Image size 2048x1536; fundus photo; FOV: 45 degrees — 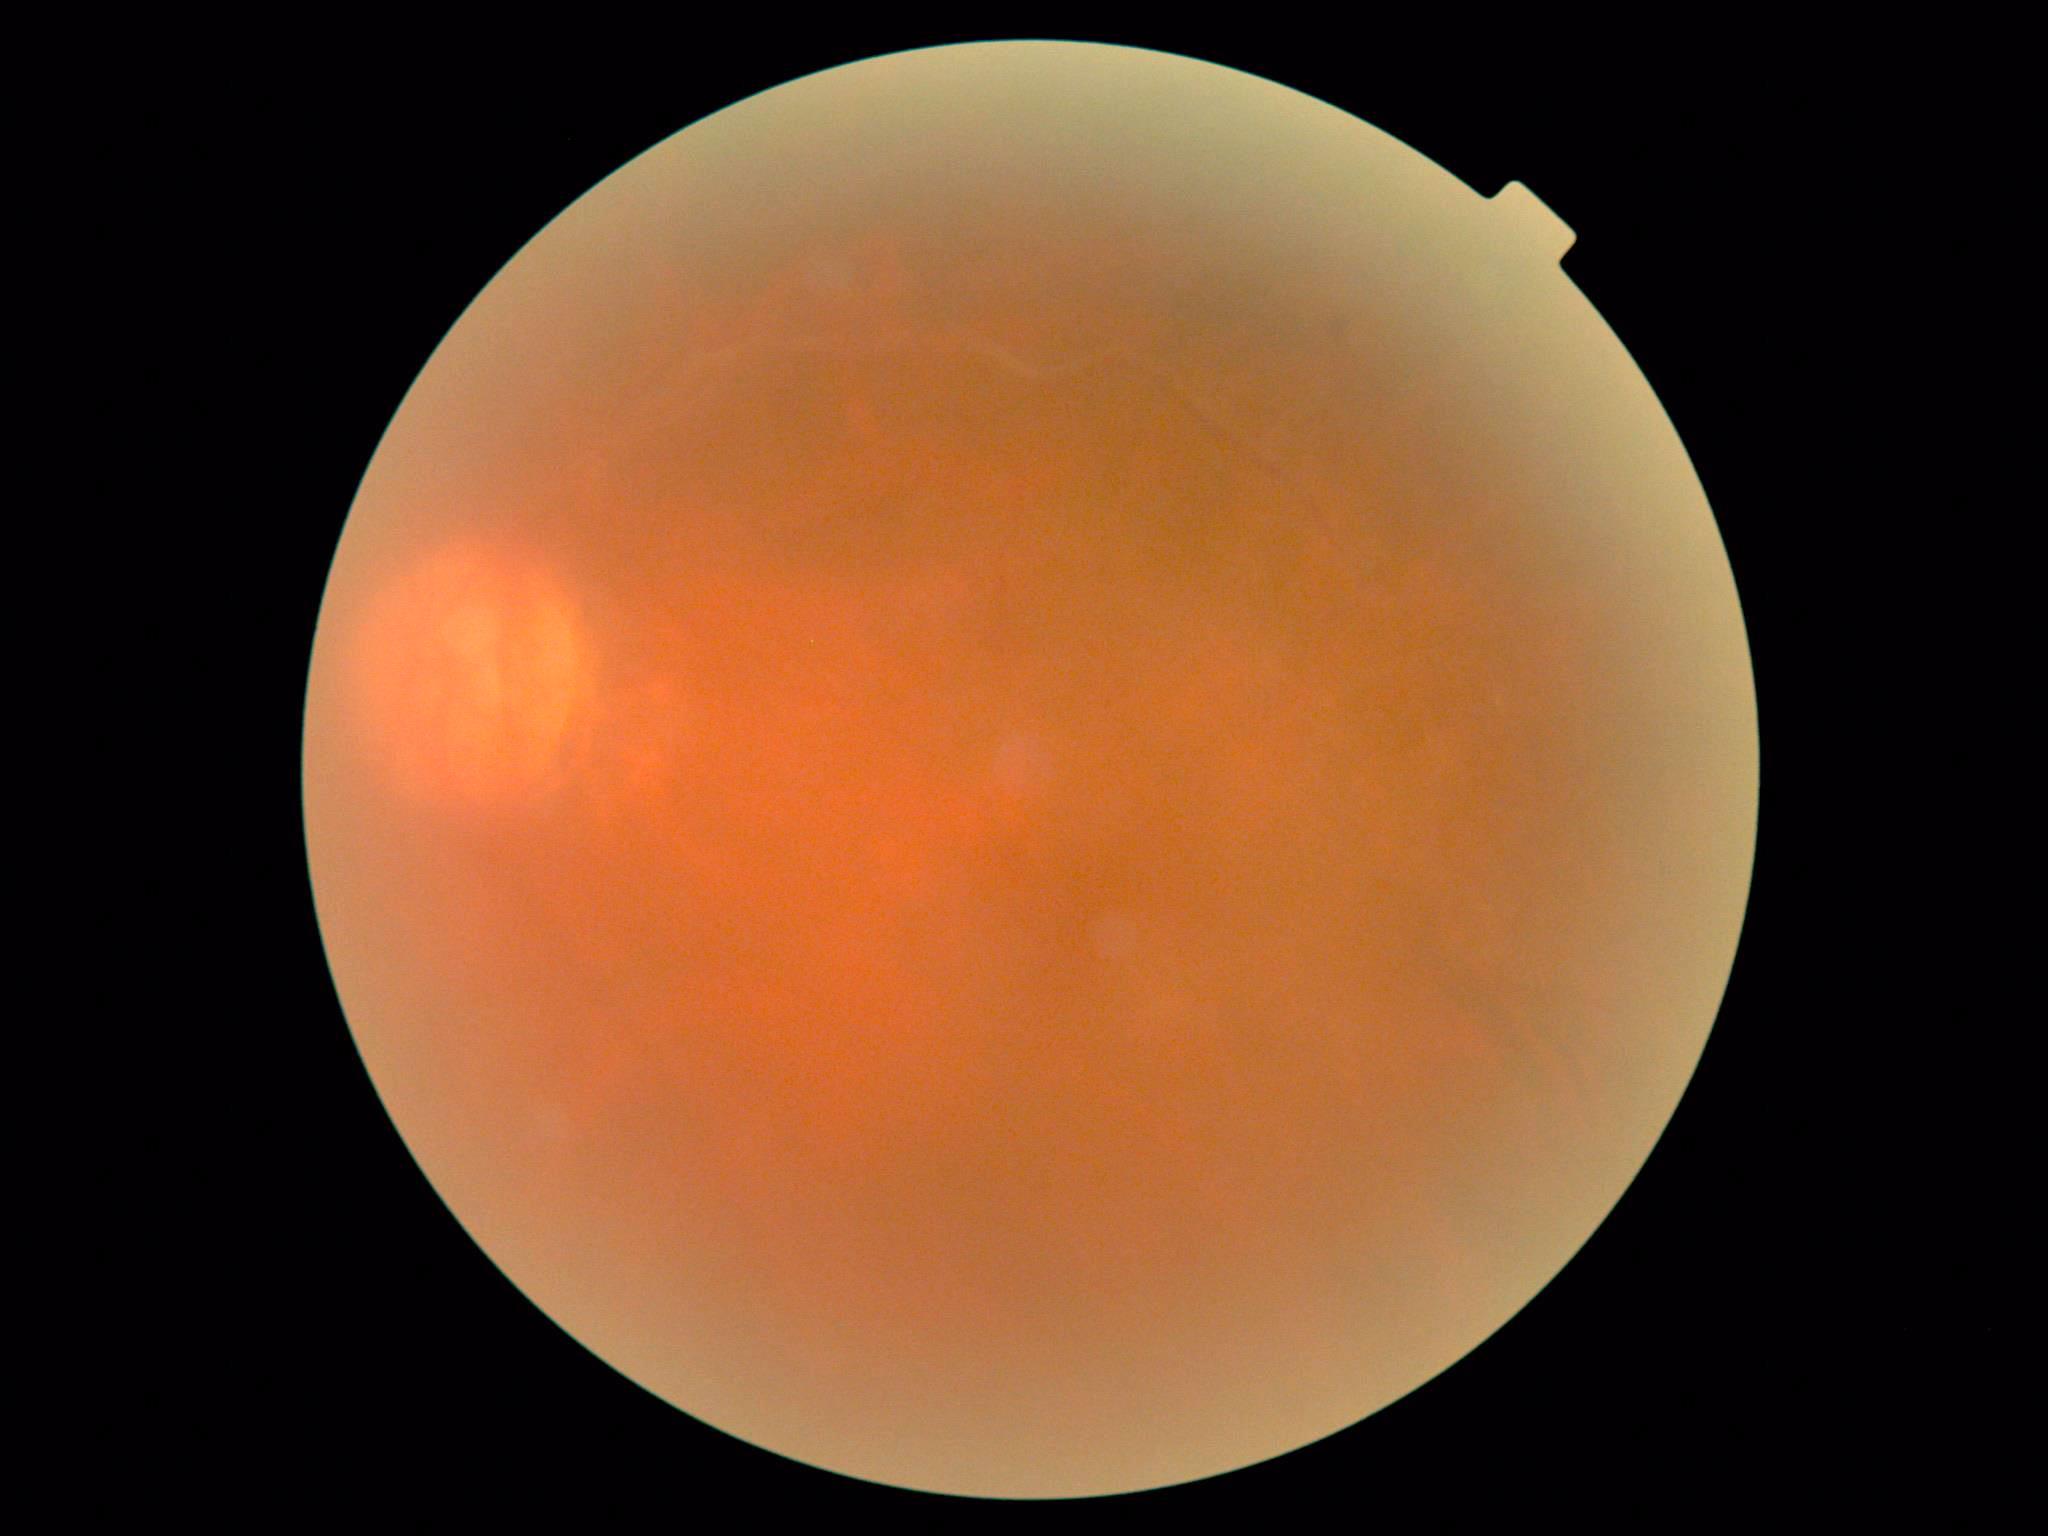   dr_grade: ungradable due to poor image quality